Wide-field contact fundus photograph of an infant: 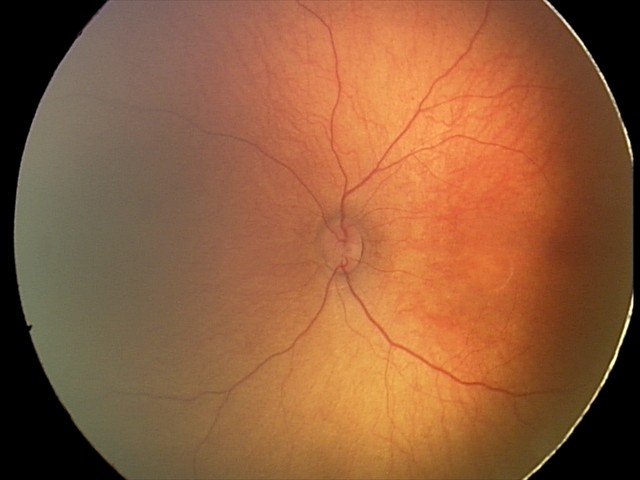
Screening examination with no abnormal retinal findings.